68 years old; refractive error: +4 -1.5 × 105° — 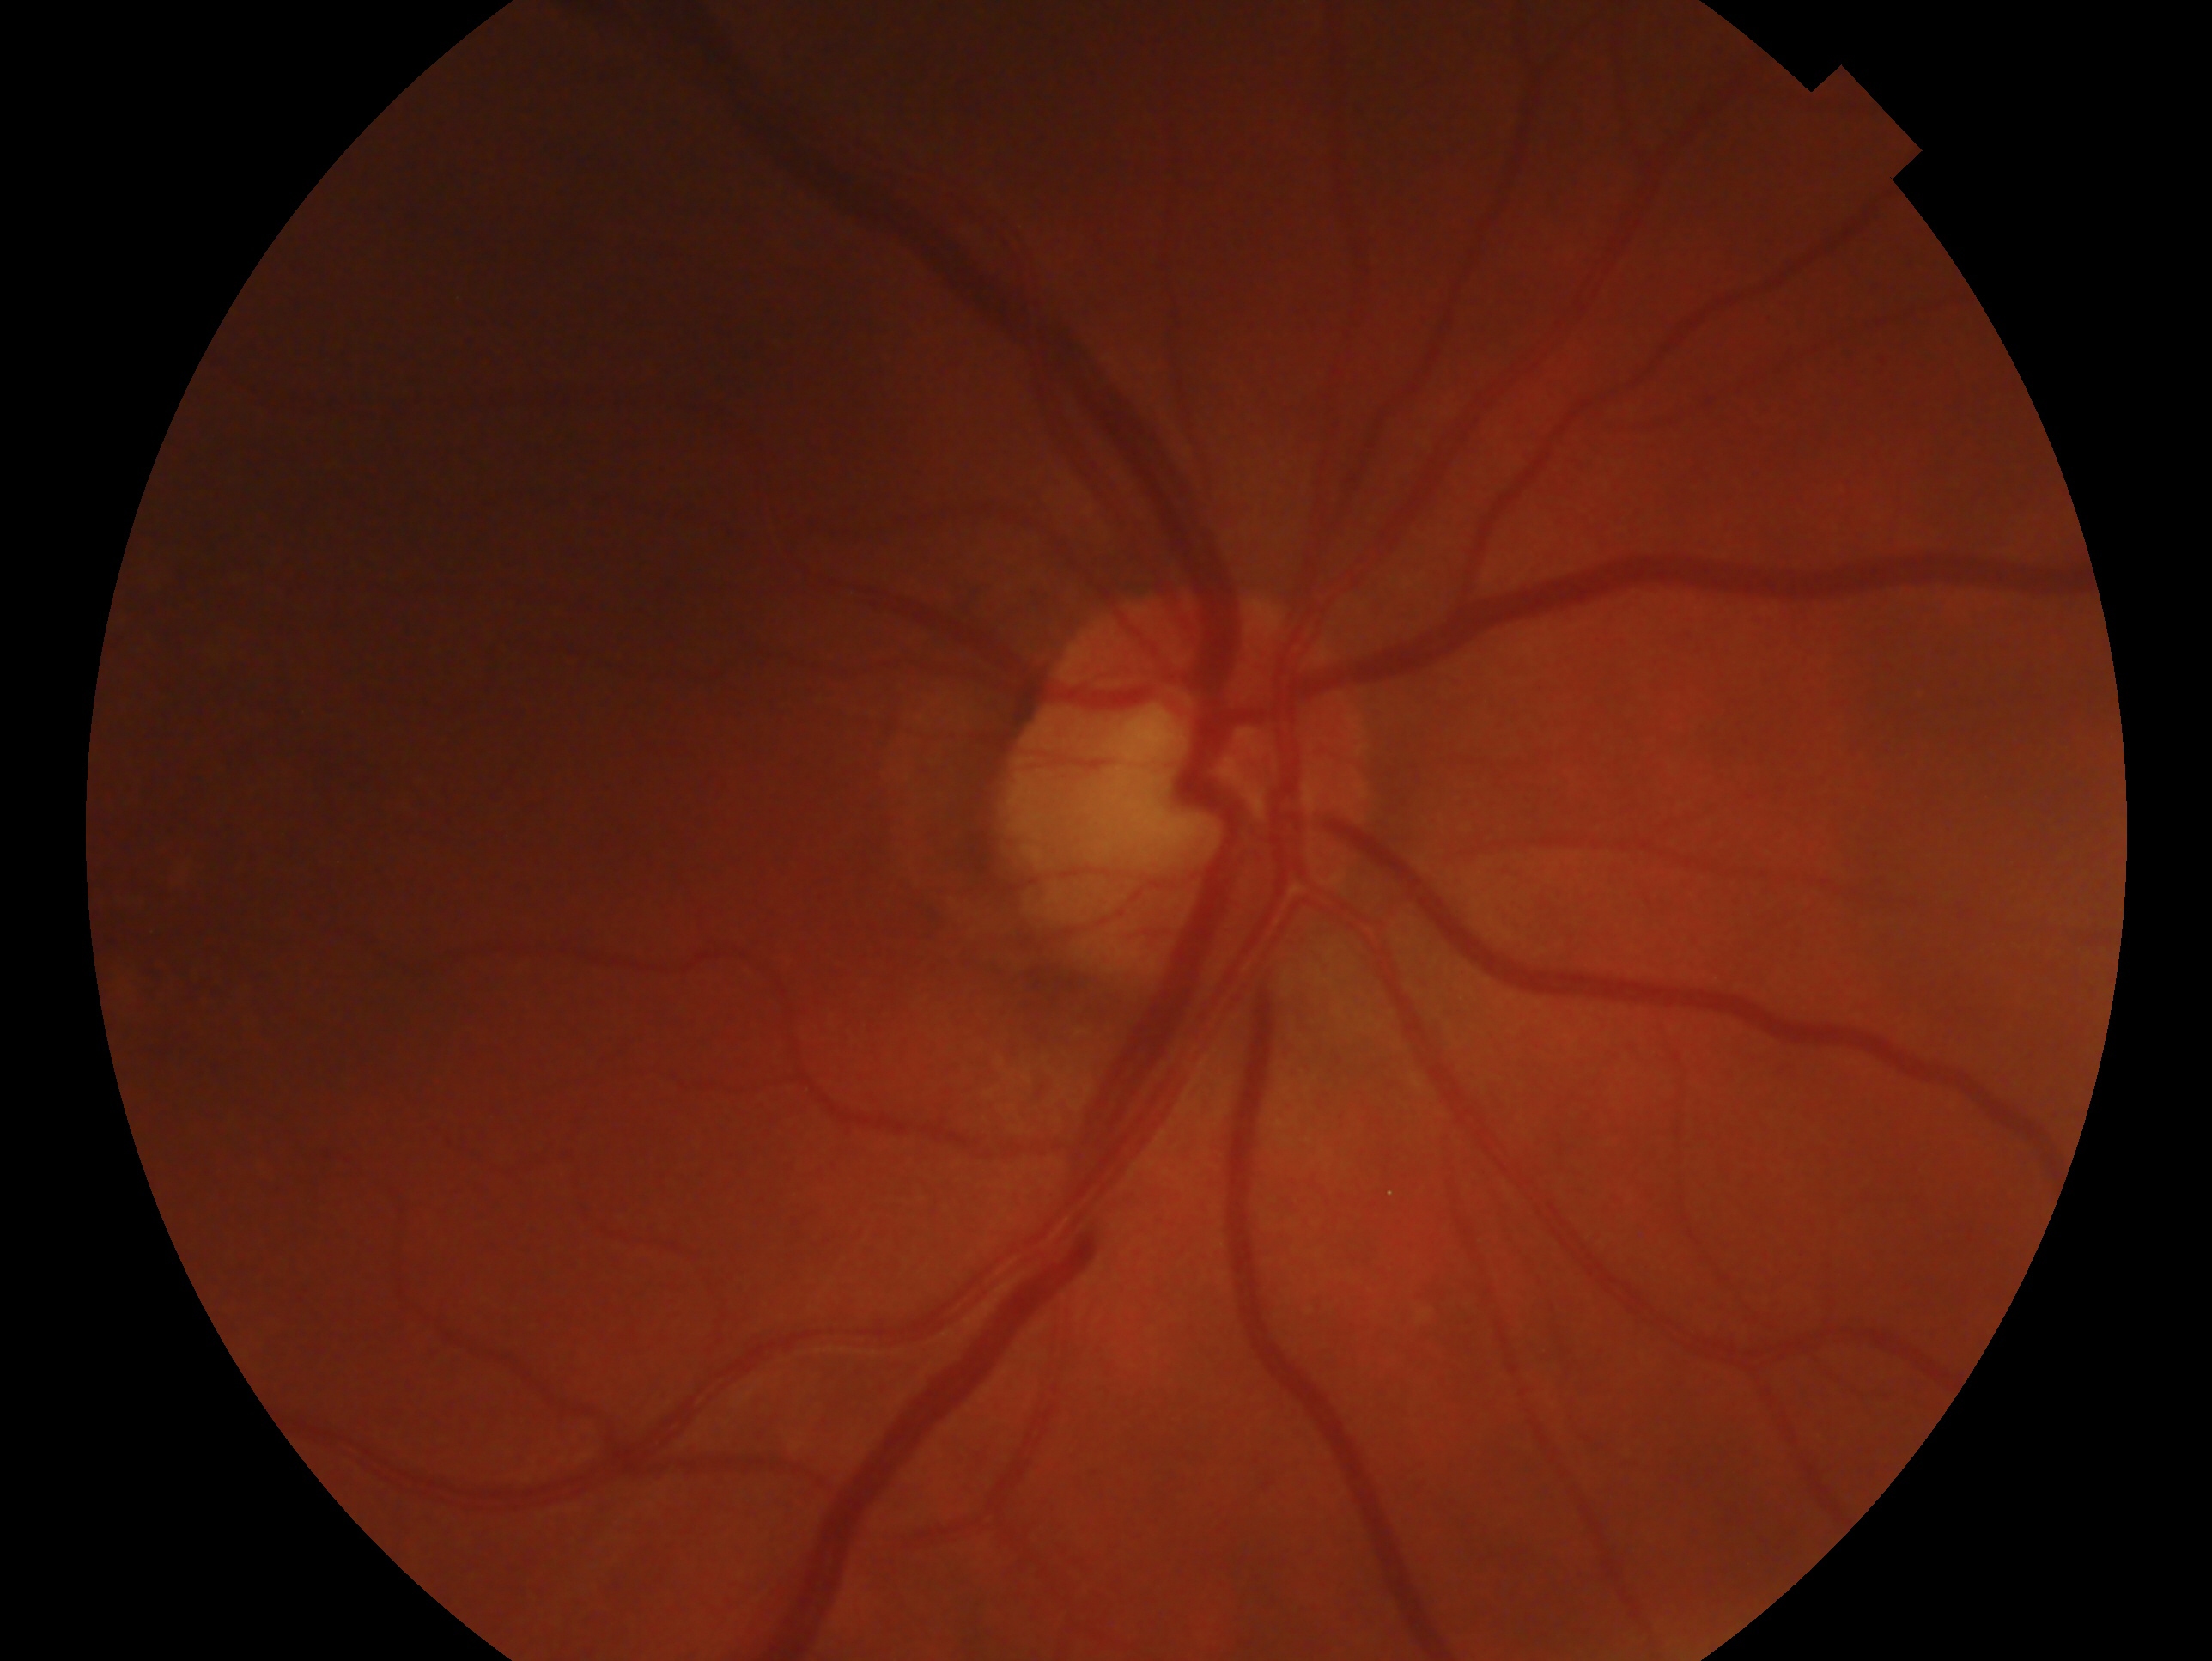 Eye: right eye. Glaucoma diagnosis: negative for glaucoma.